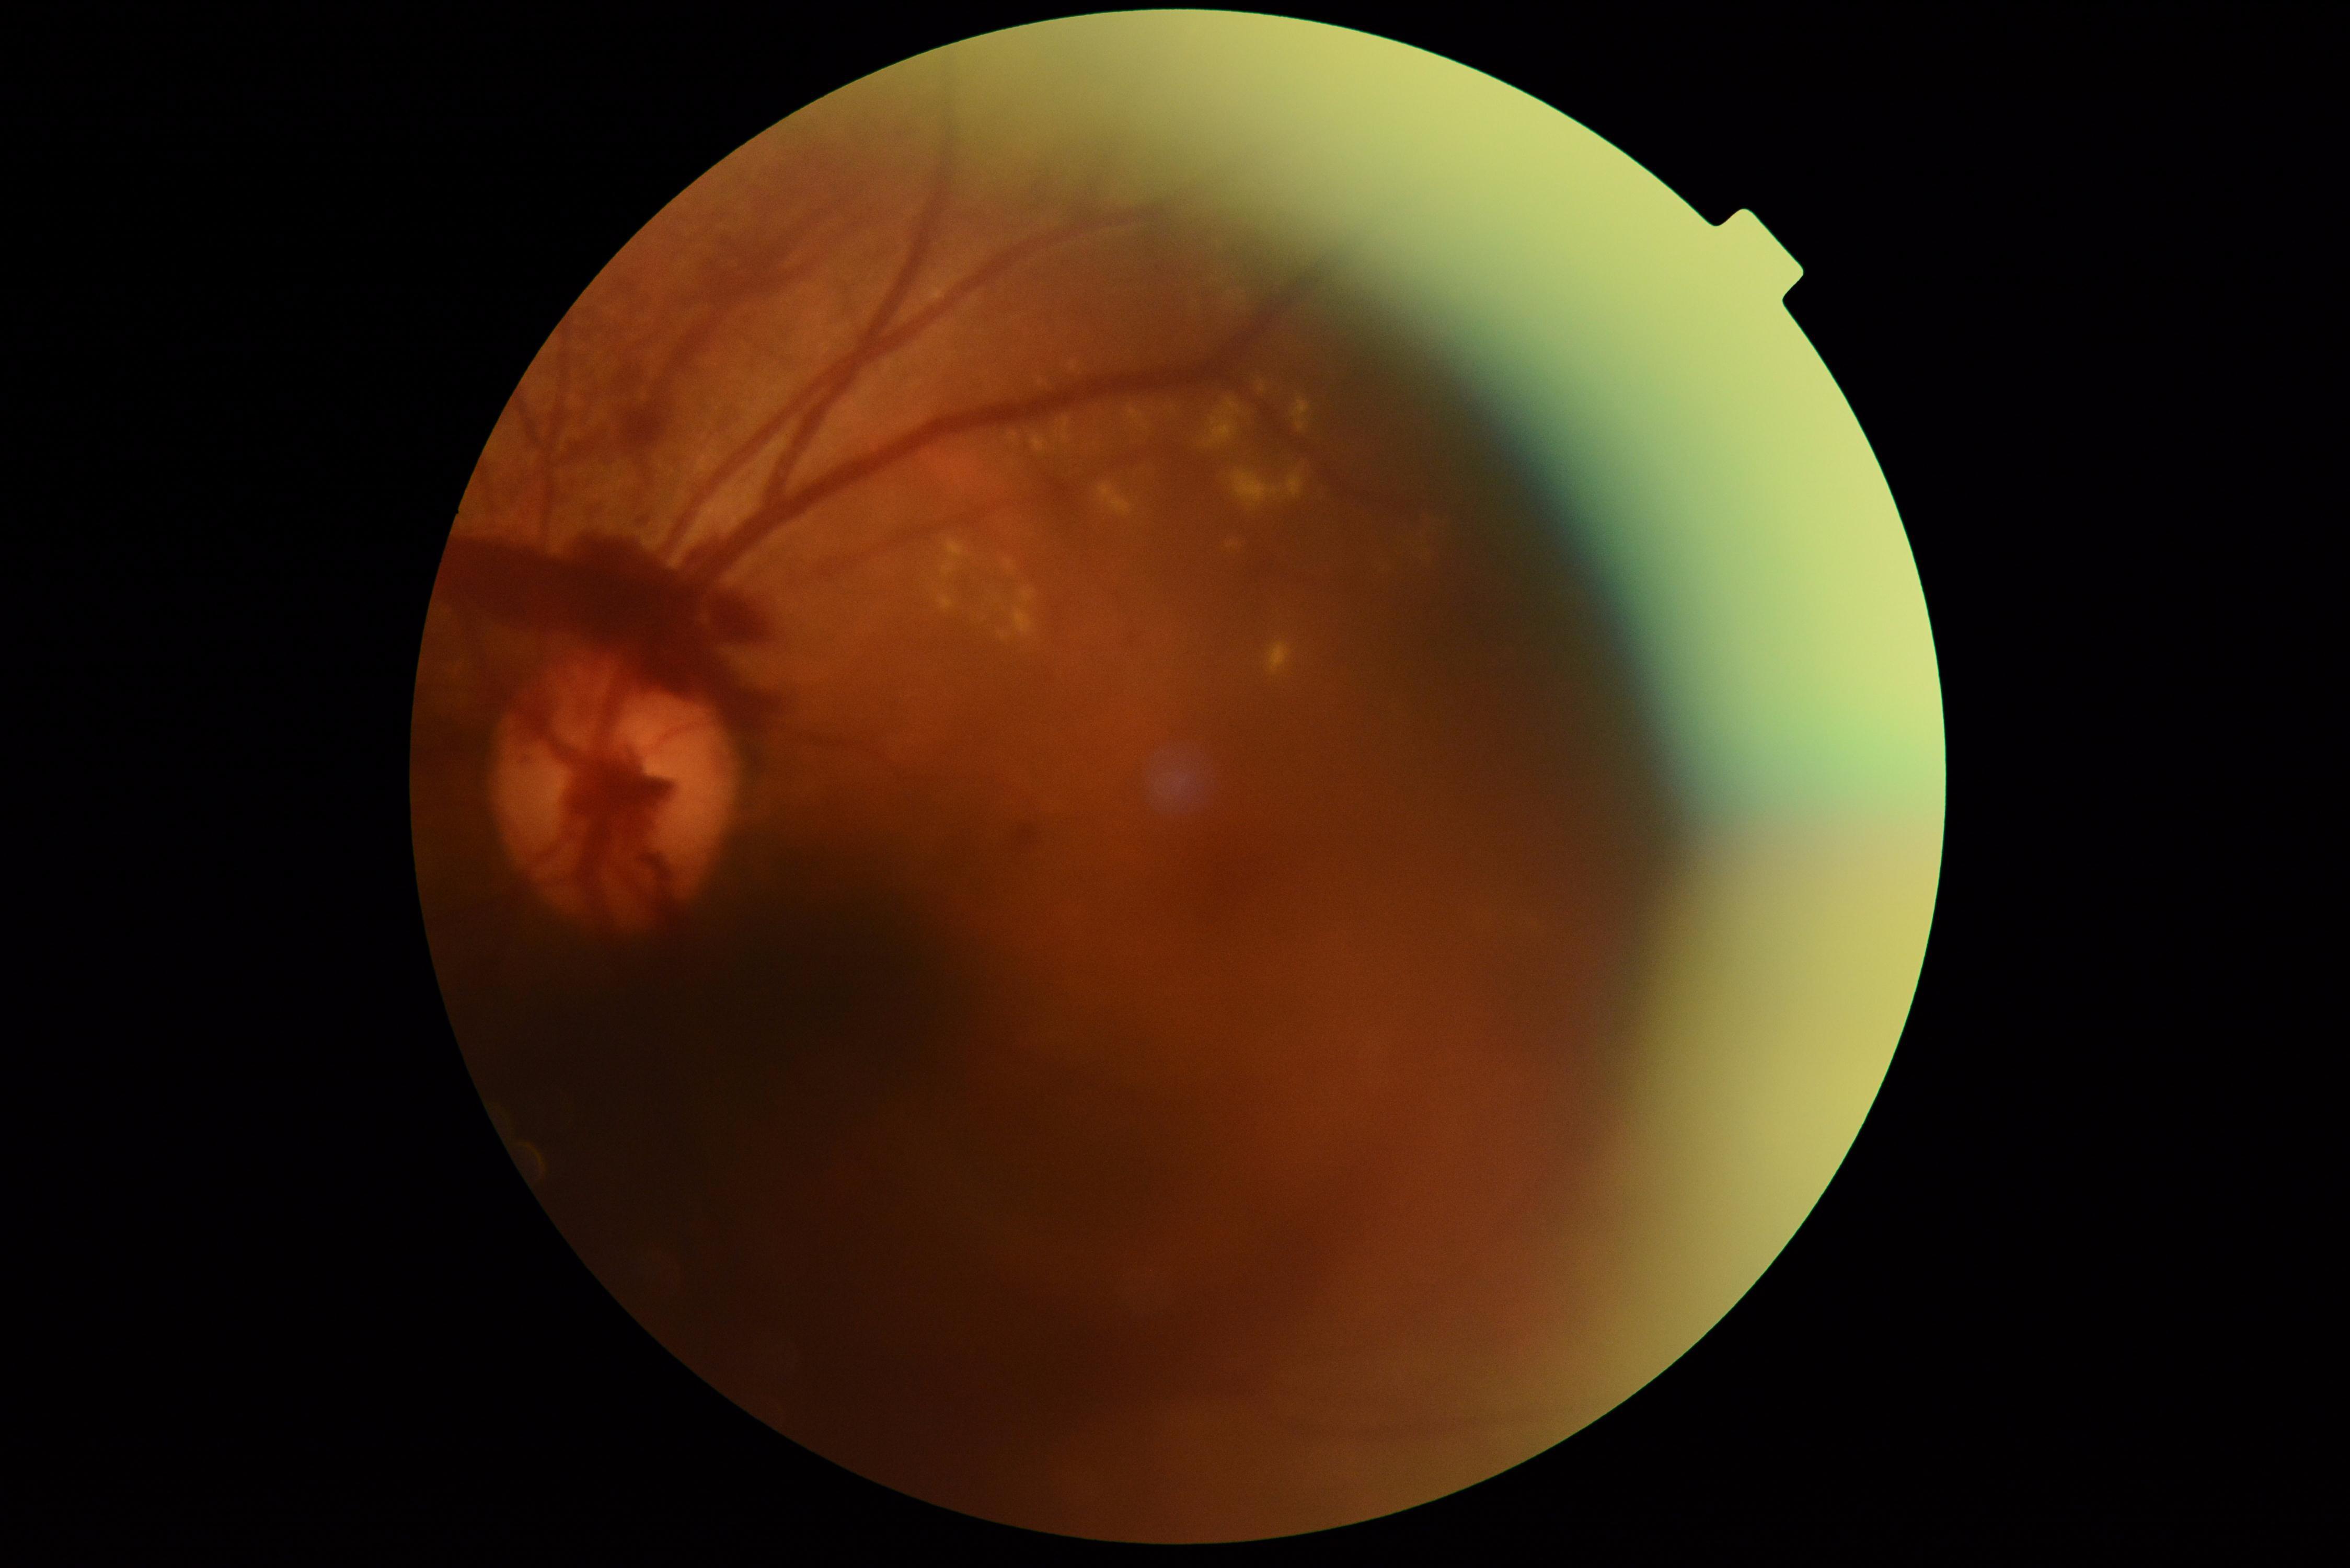
Disease class: proliferative diabetic retinopathy. DR grade: 4.